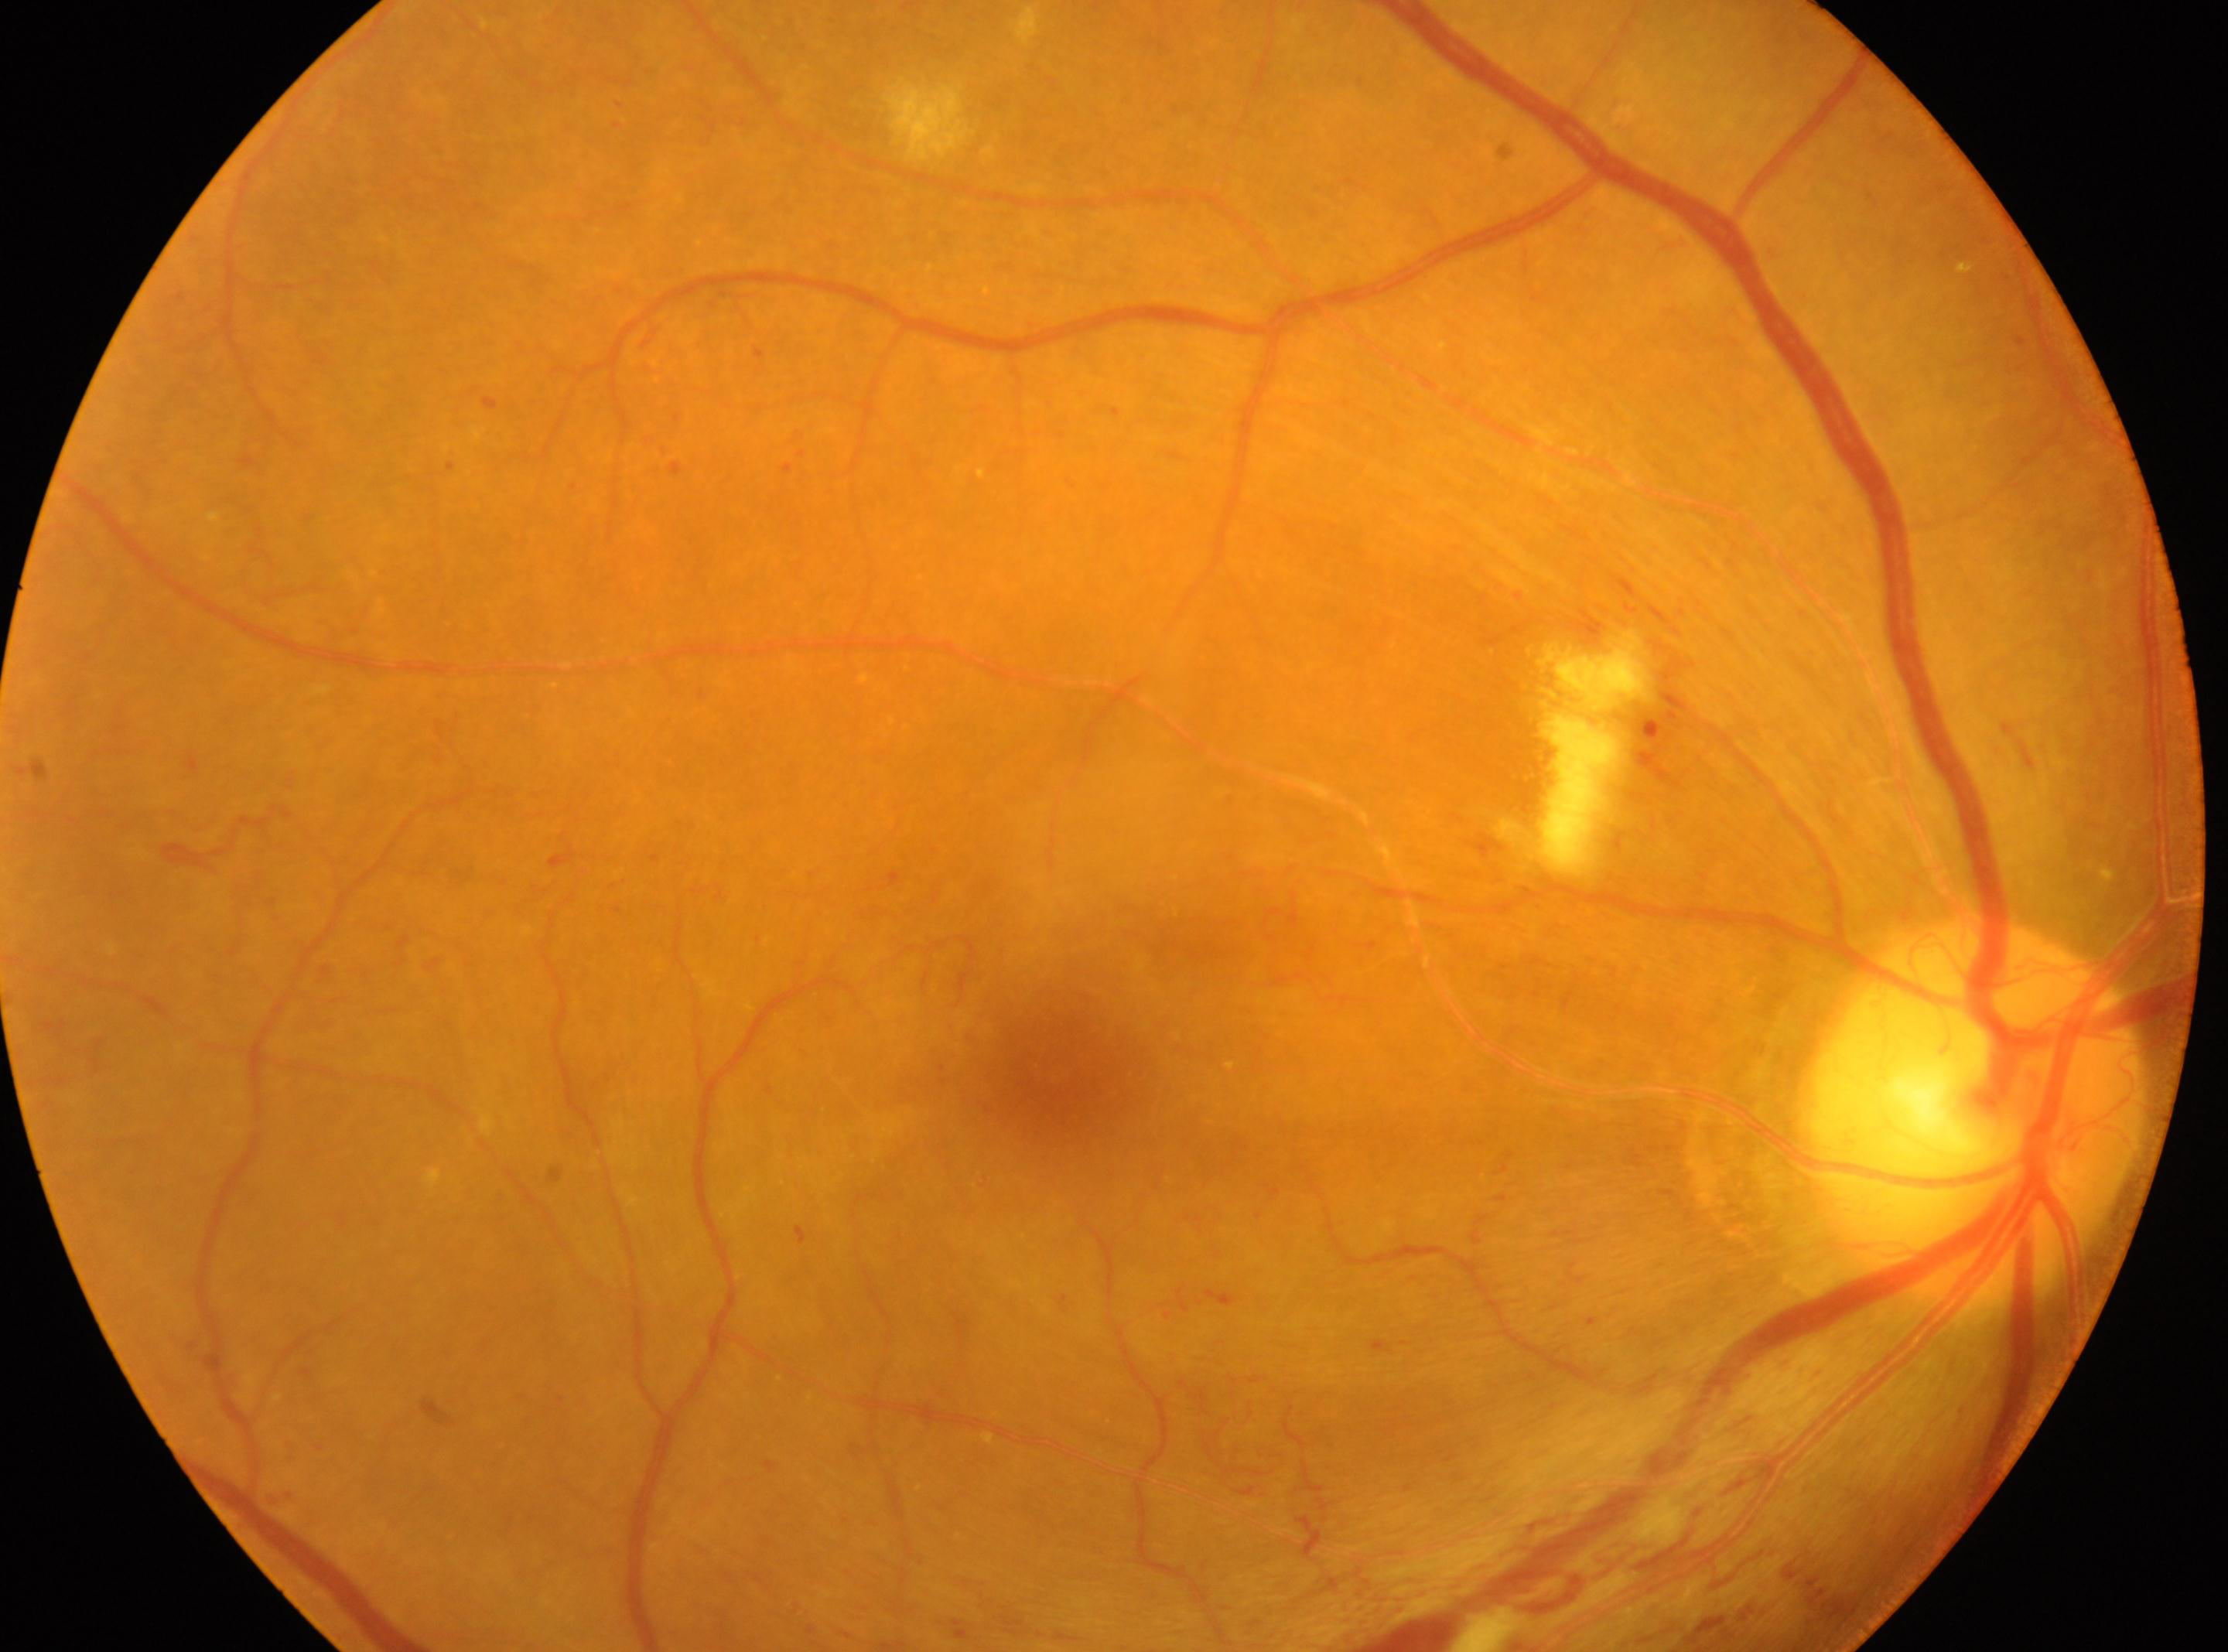
Fovea centralis located at (1058, 1067). DR grade is 4 (PDR) — neovascularization and/or vitreous/pre-retinal hemorrhage. The disc center is at (1975, 1111). The retinopathy is classified as proliferative diabetic retinopathy. The image shows the right eye.